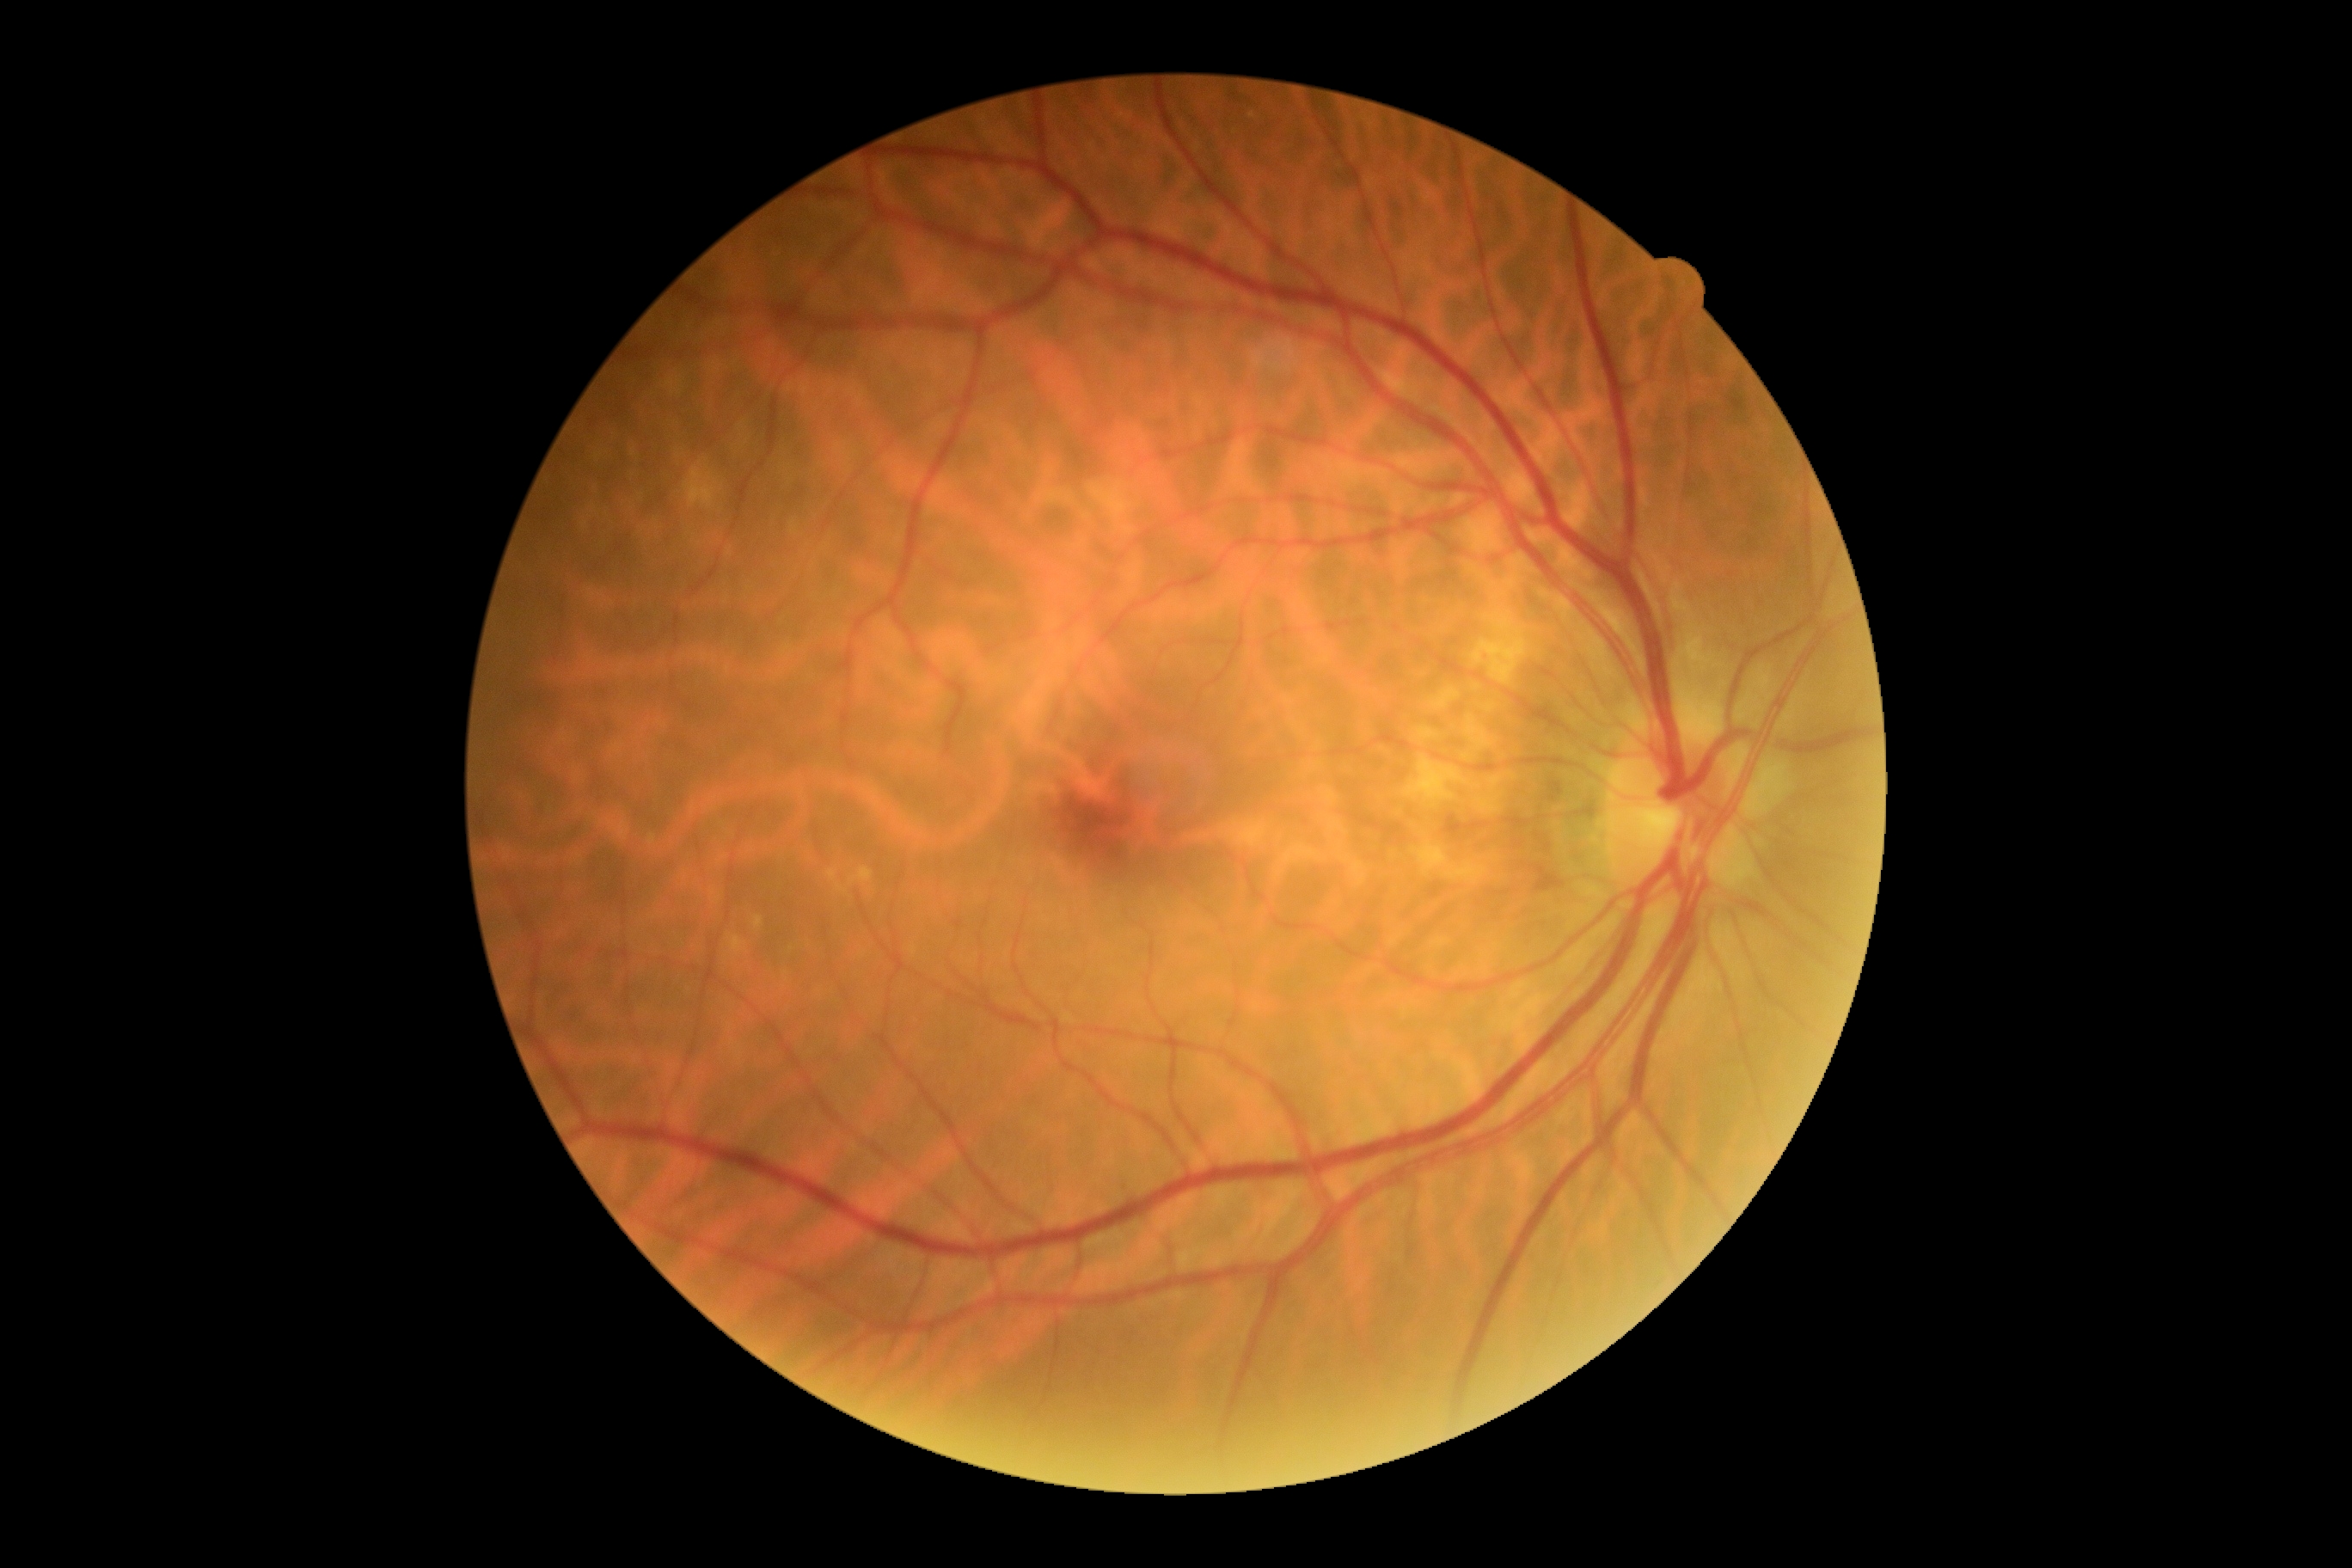 No signs of diabetic retinopathy. DR severity is grade 0 (no apparent retinopathy).